1240 by 1240 pixels · camera: Phoenix ICON (100° FOV) · wide-field contact fundus photograph of an infant.
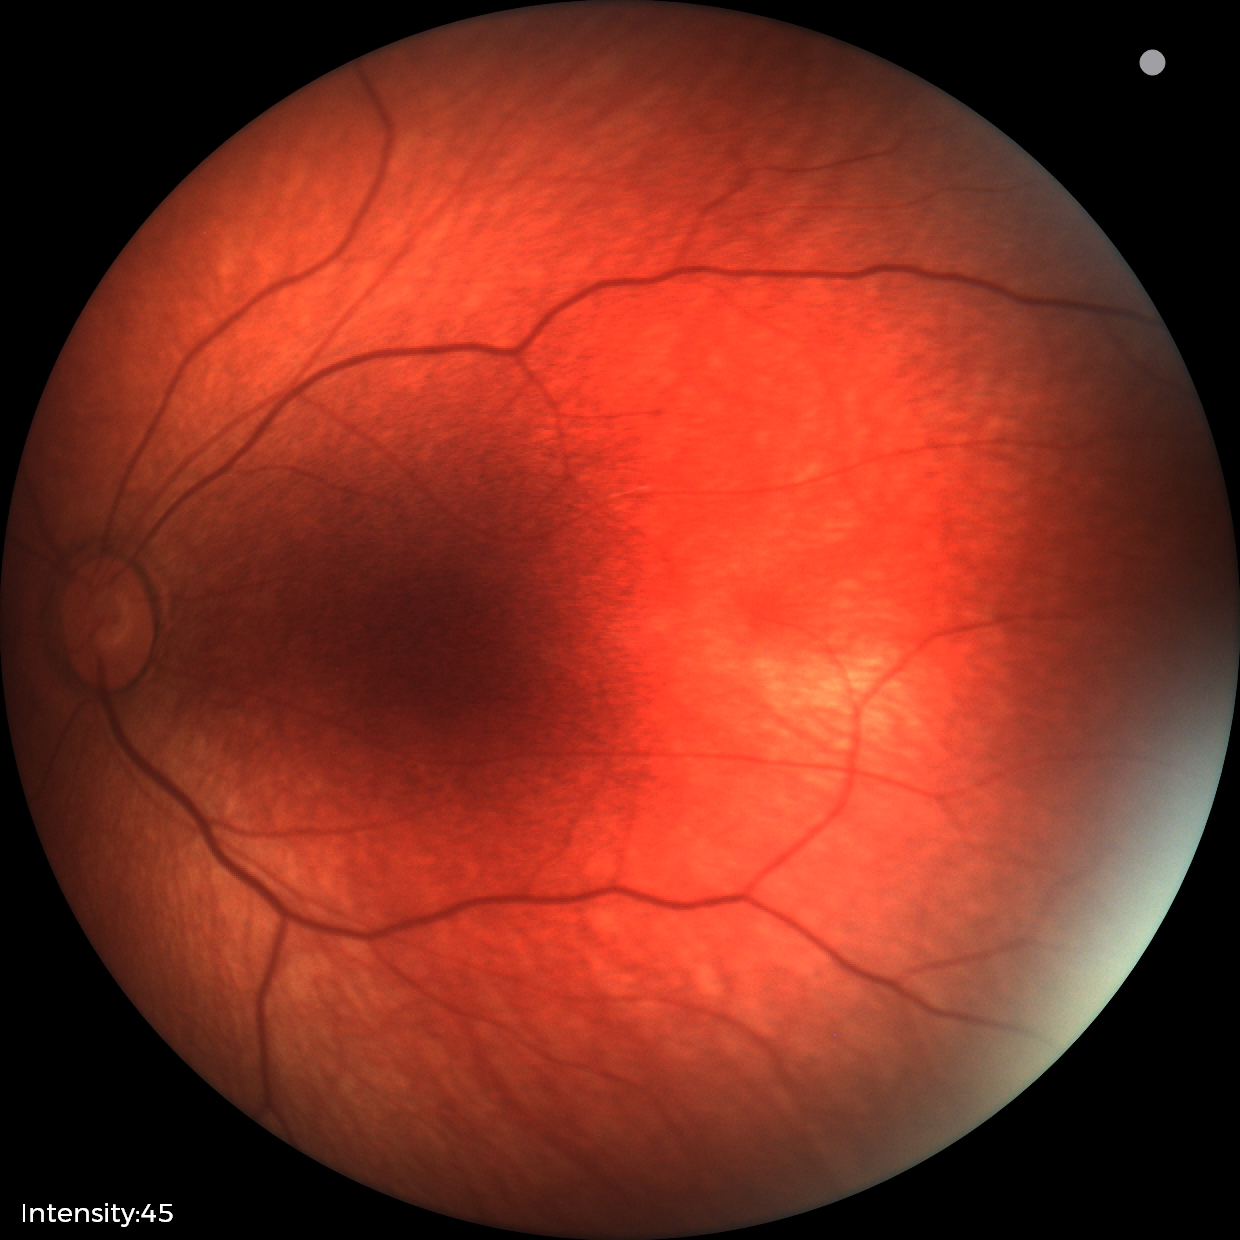
Screening examination diagnosed as physiological.